FOV: 45 degrees:
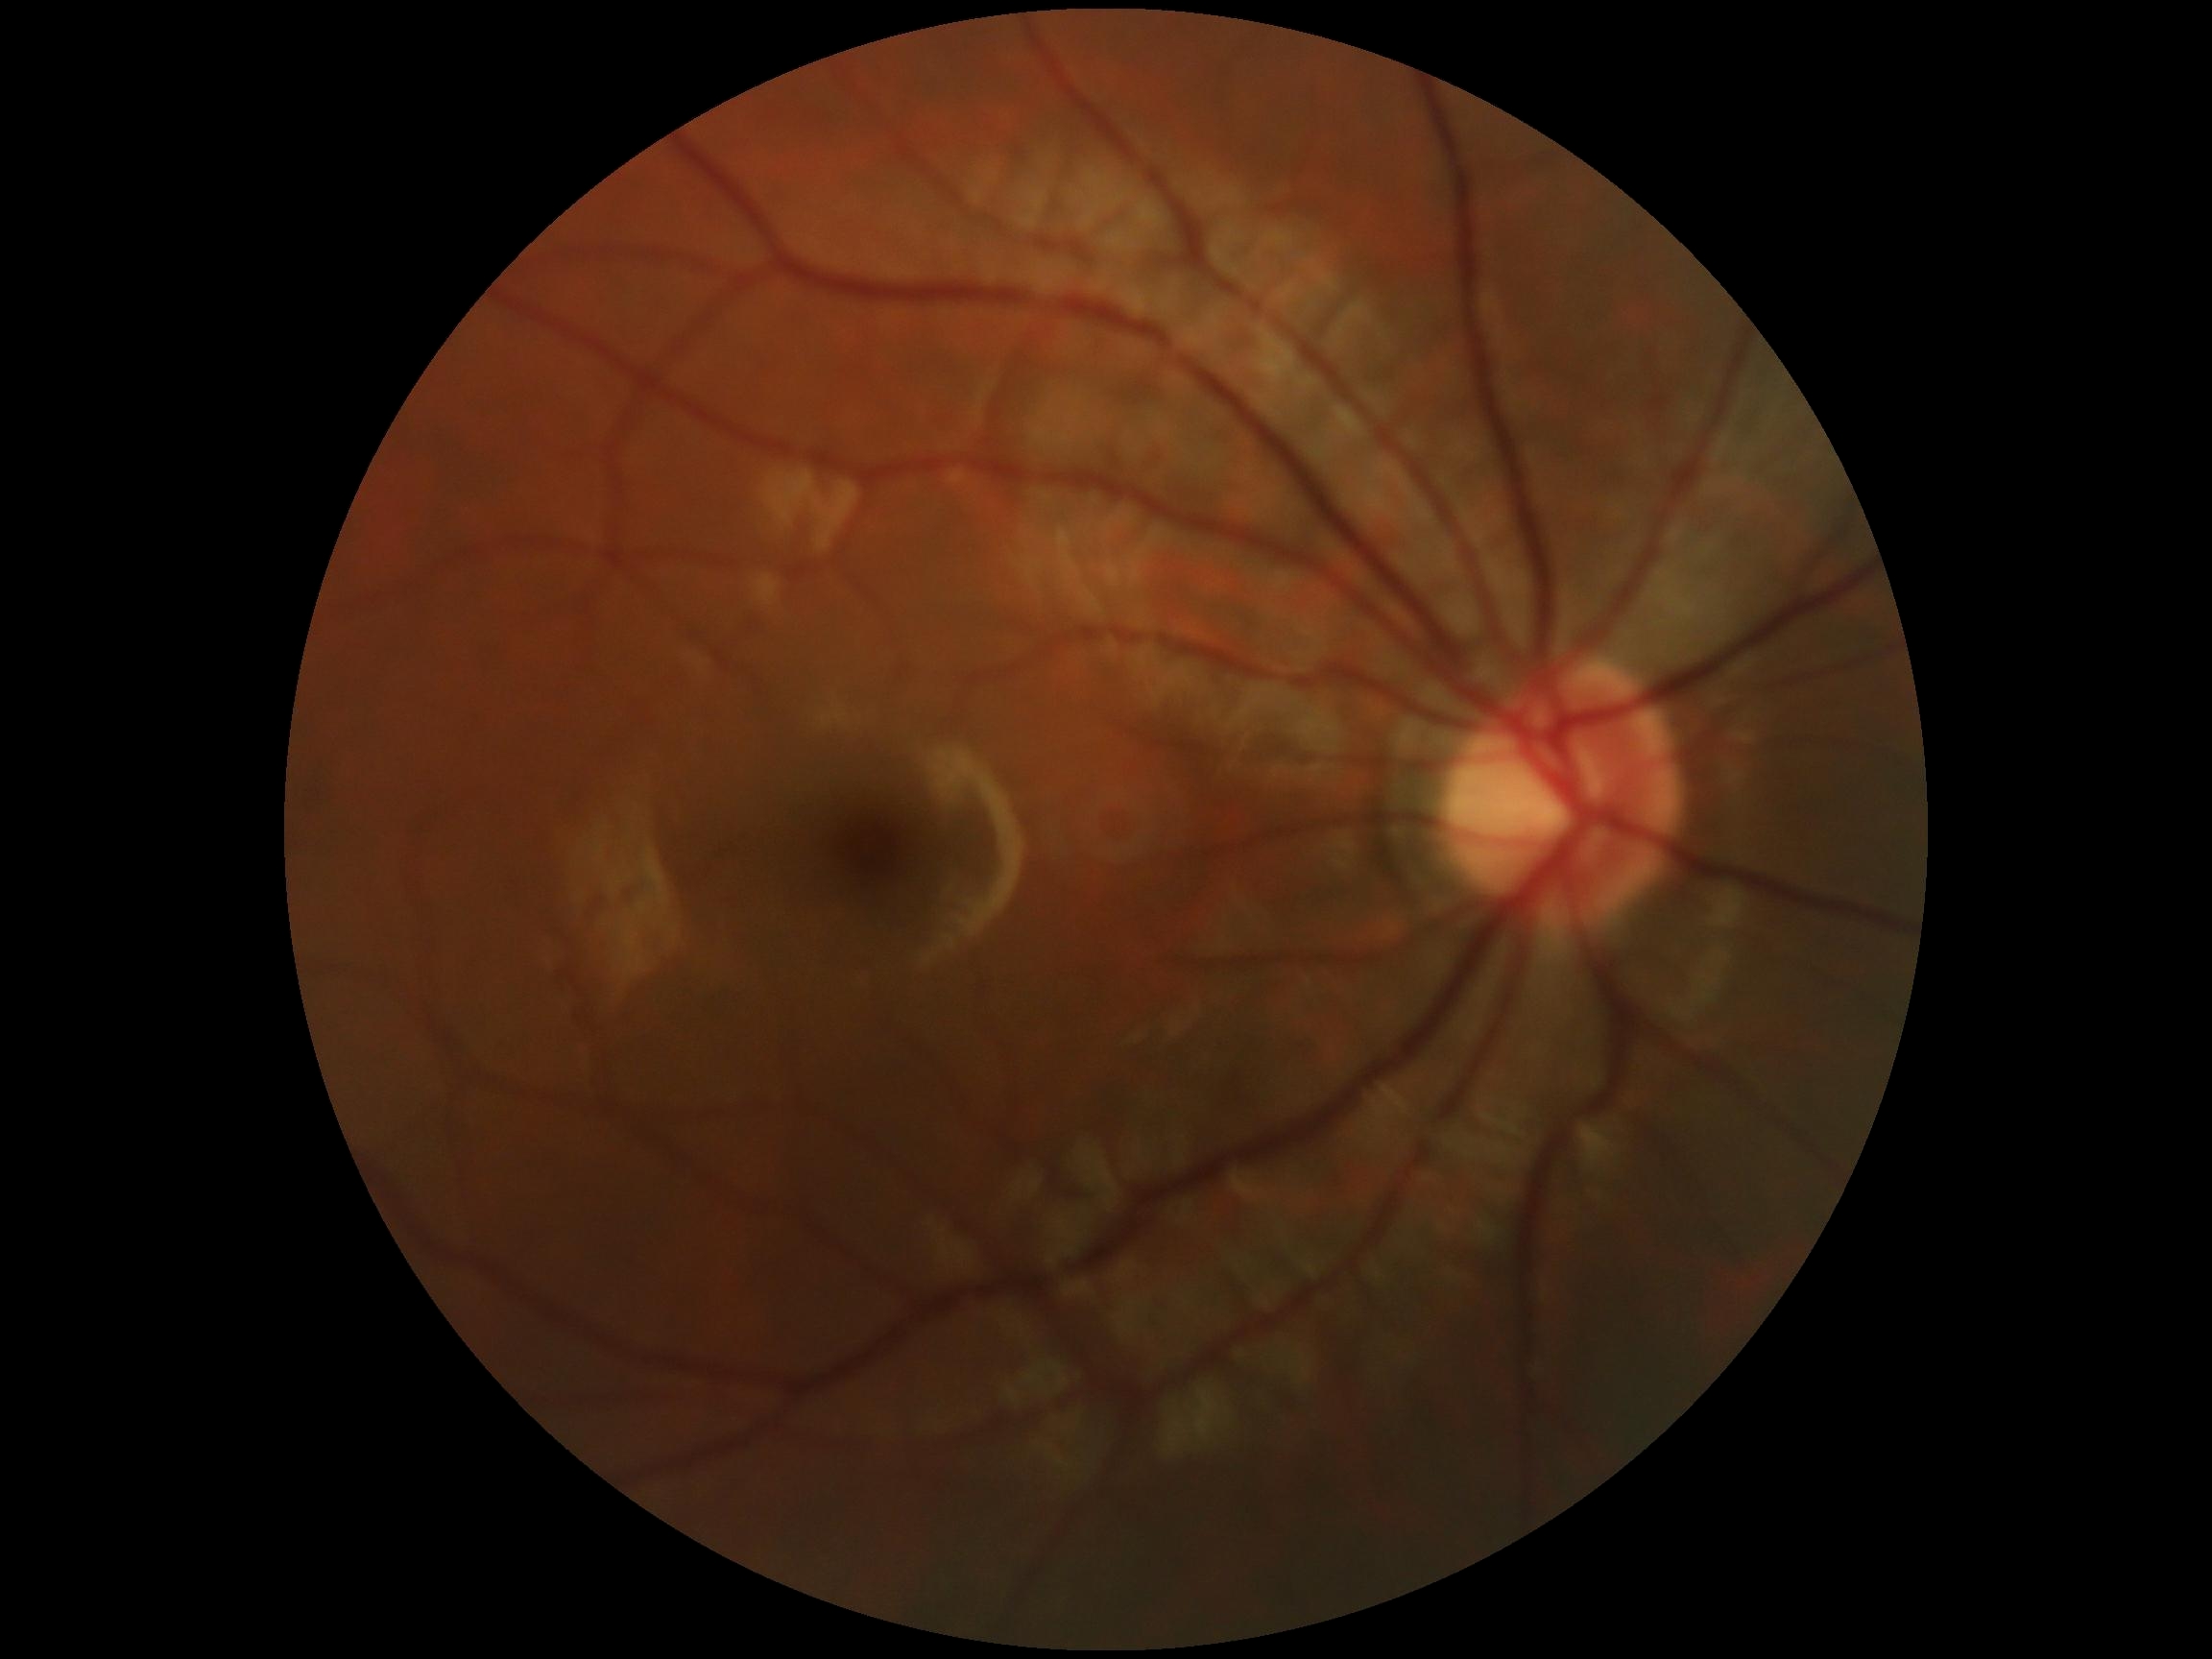

No apparent diabetic retinopathy. Diabetic retinopathy (DR) is 0.